1725x1721px — 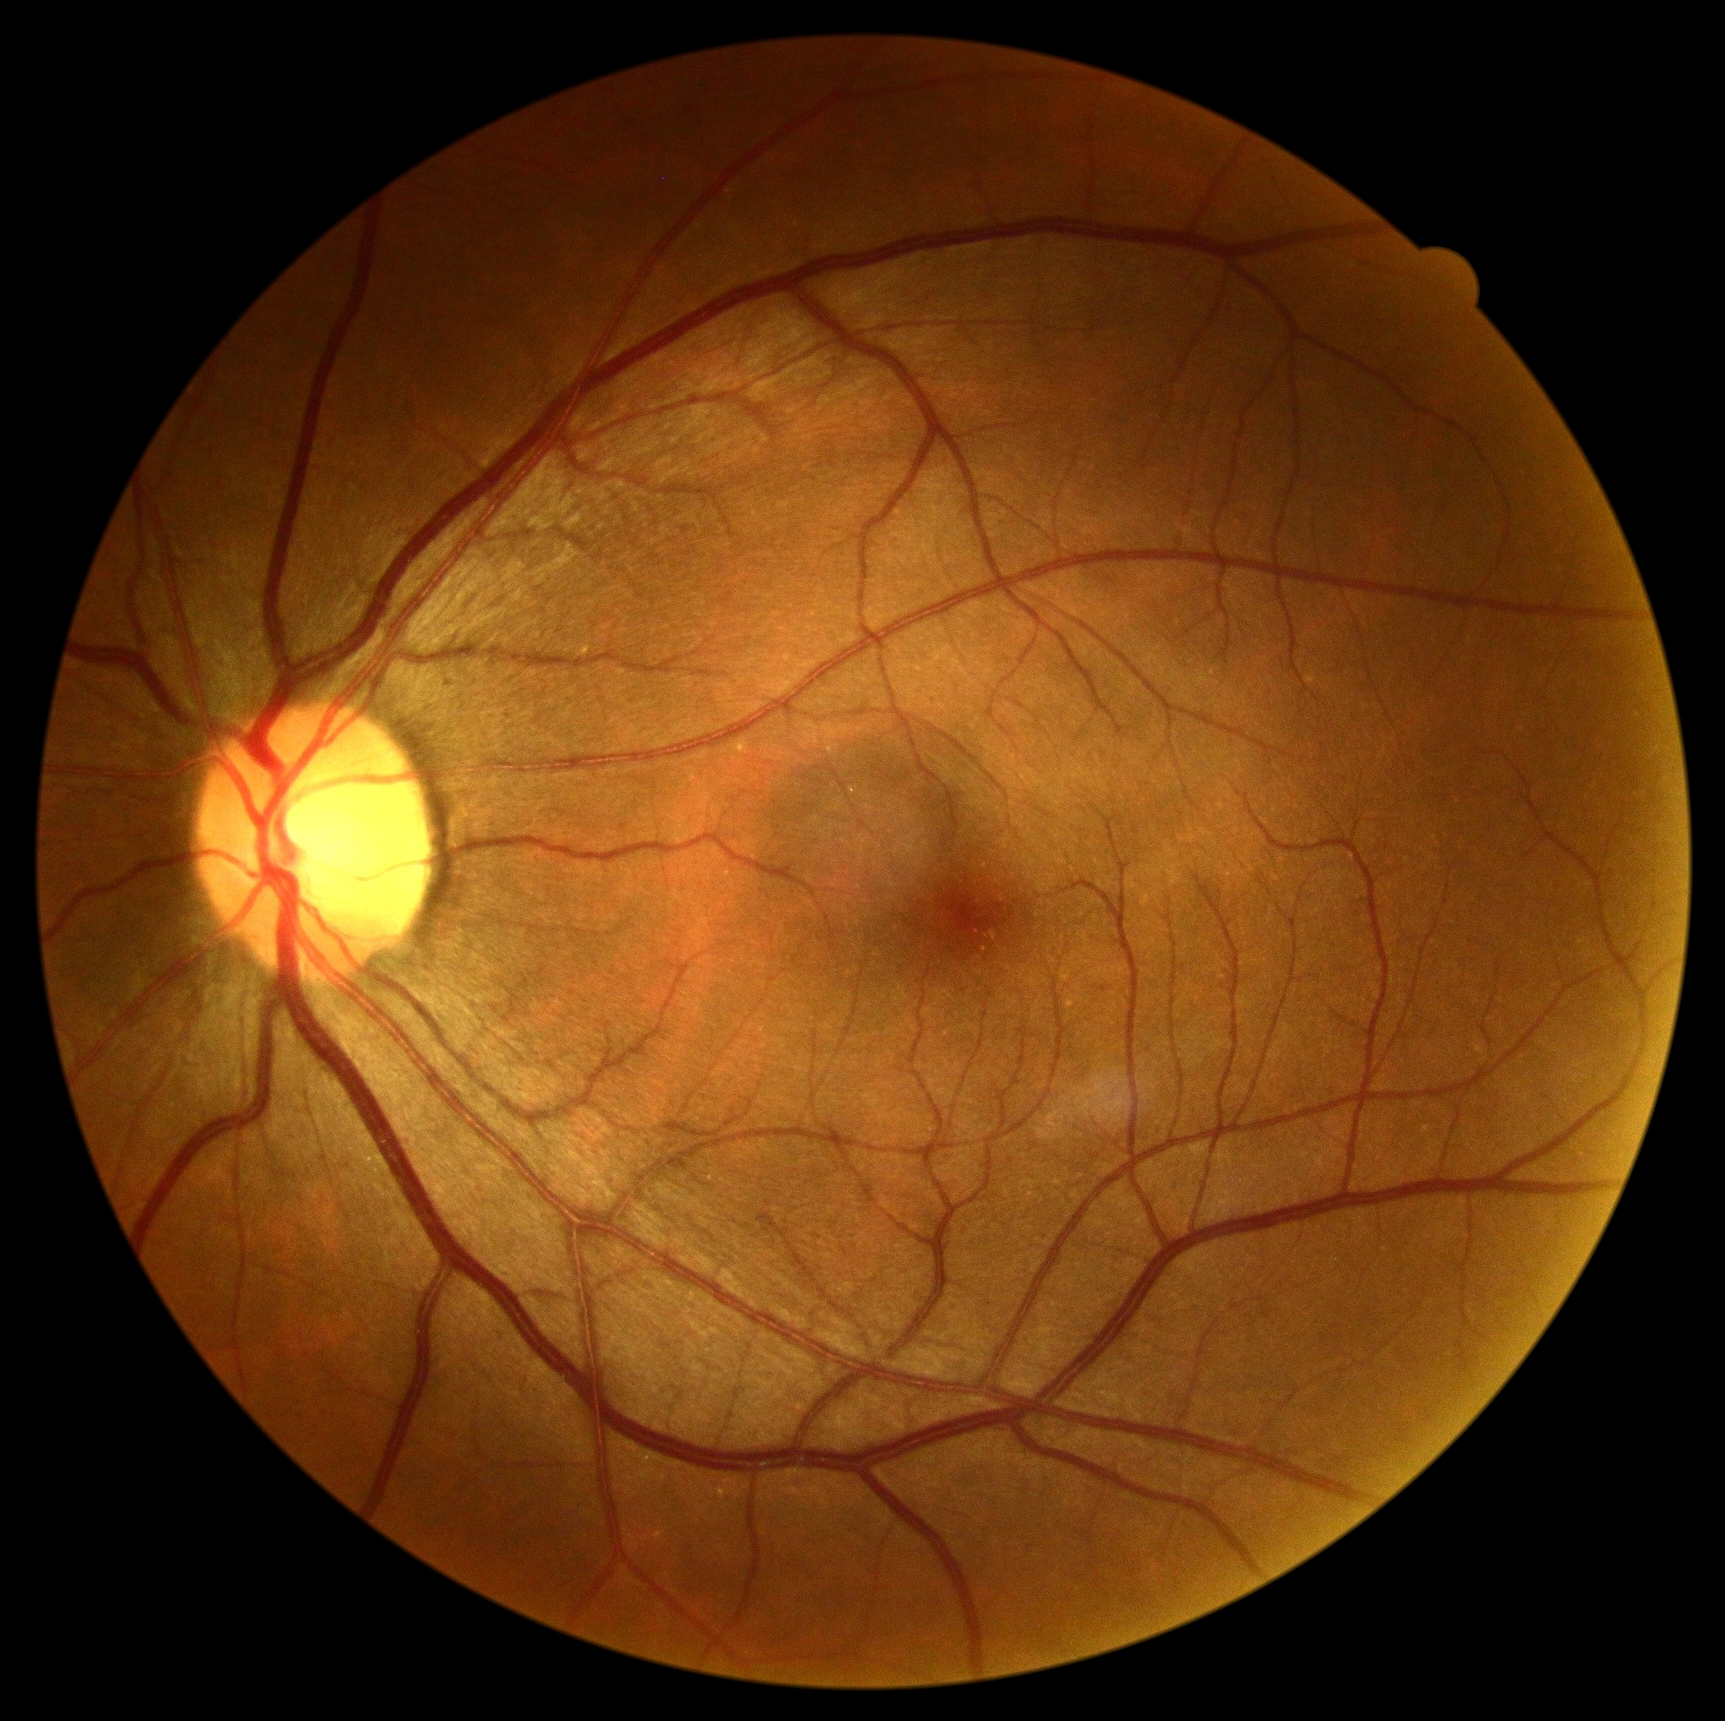

diabetic retinopathy (DR): grade 0 (no apparent retinopathy)